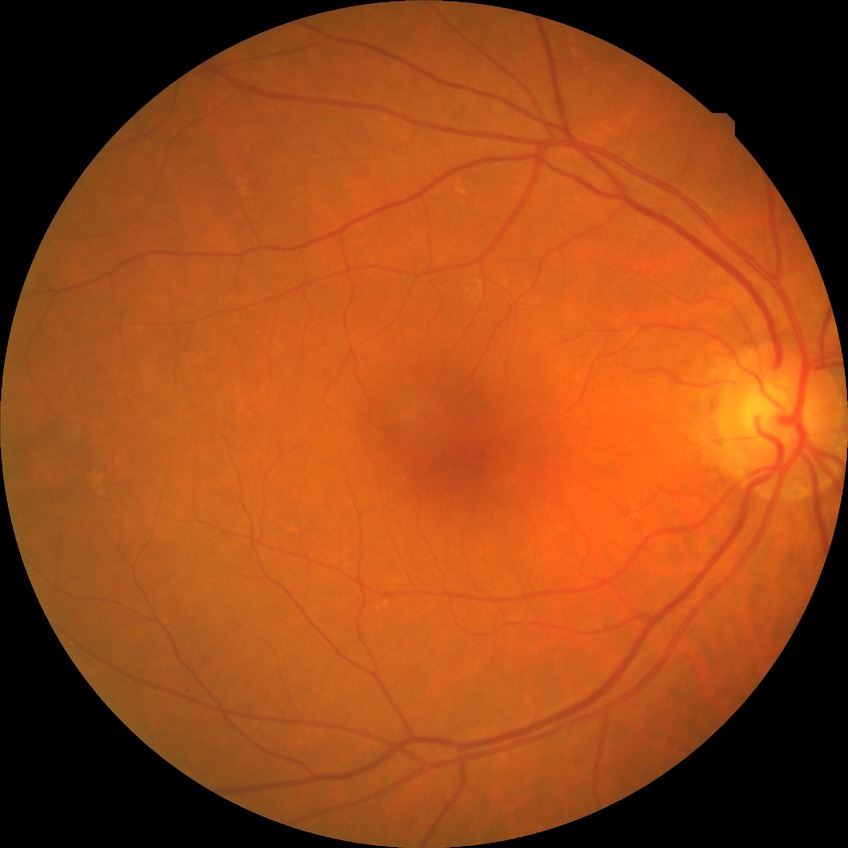

diabetic retinopathy (DR)=NDR (no diabetic retinopathy).